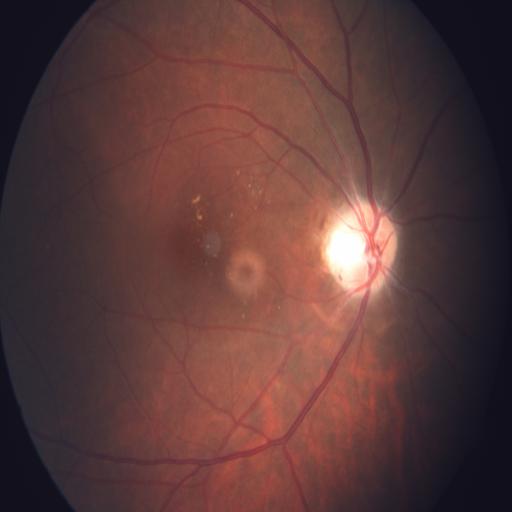

There is evidence of exudation & macular edema.